Fundus photo. 45-degree field of view. 1380x1382
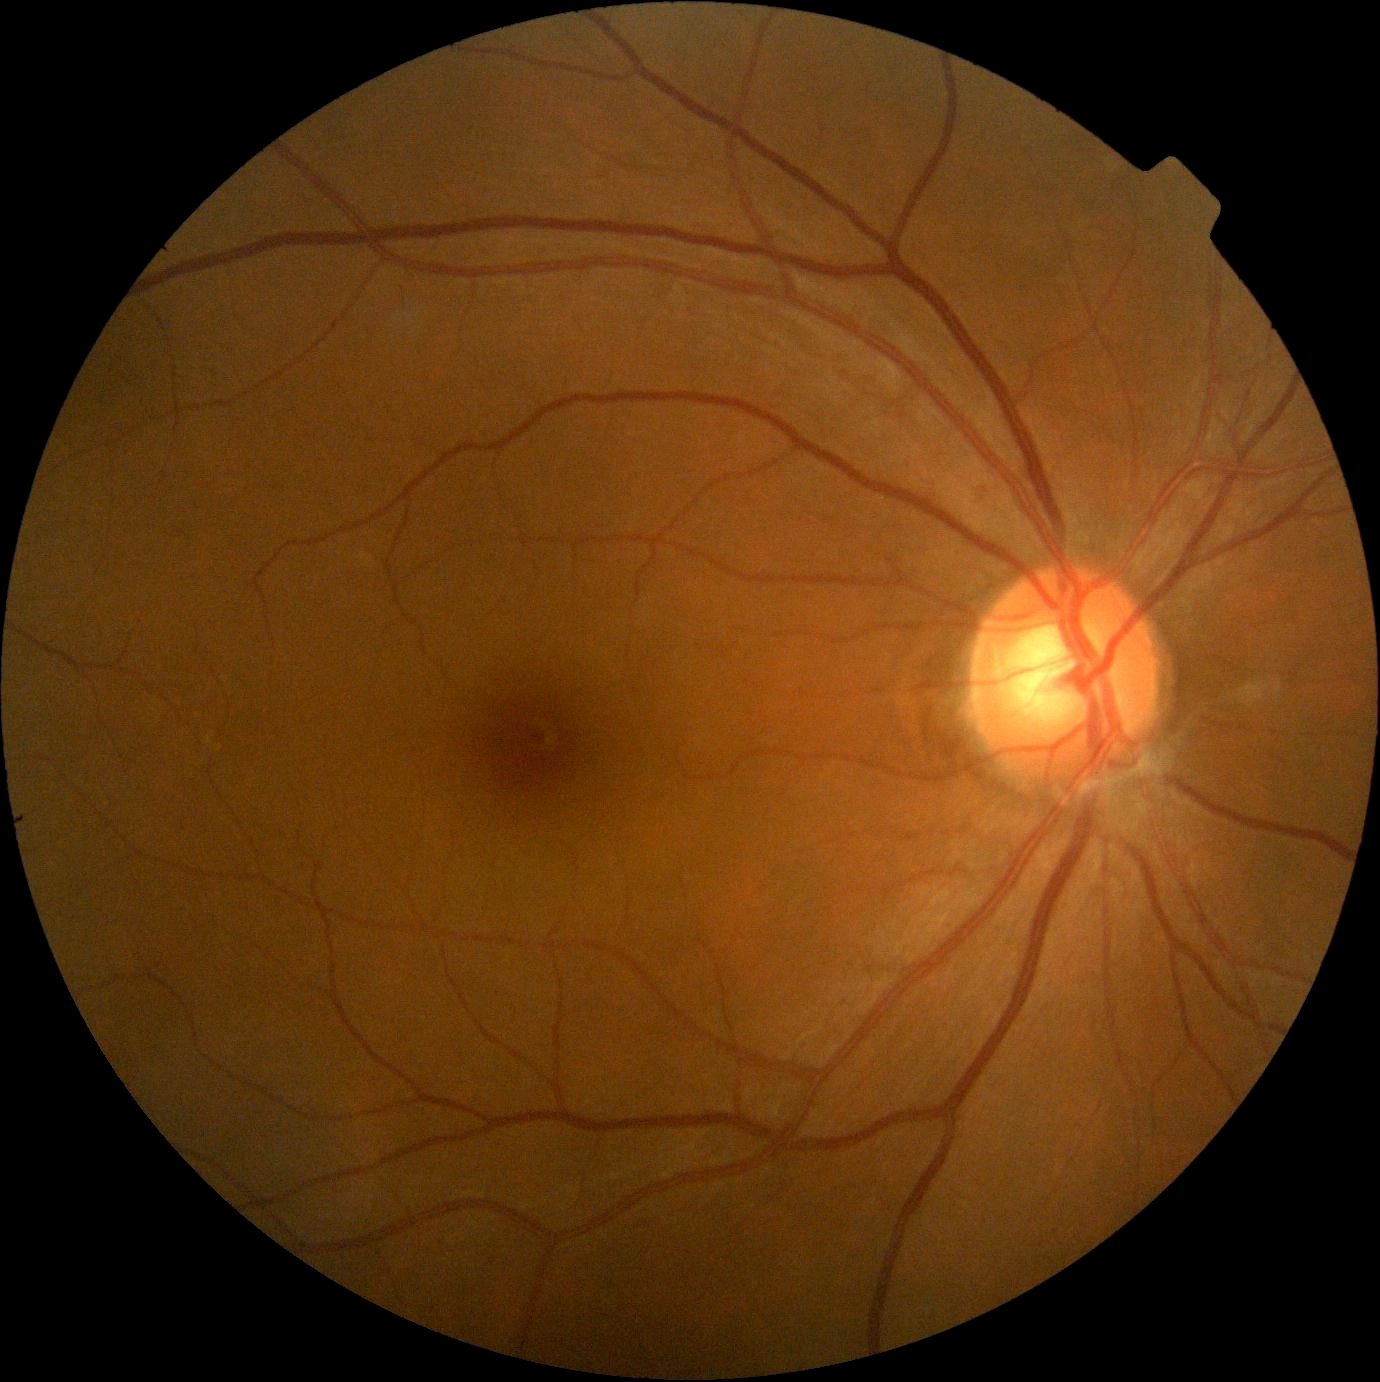

DR grade is 0/4 — no visible signs of diabetic retinopathy.